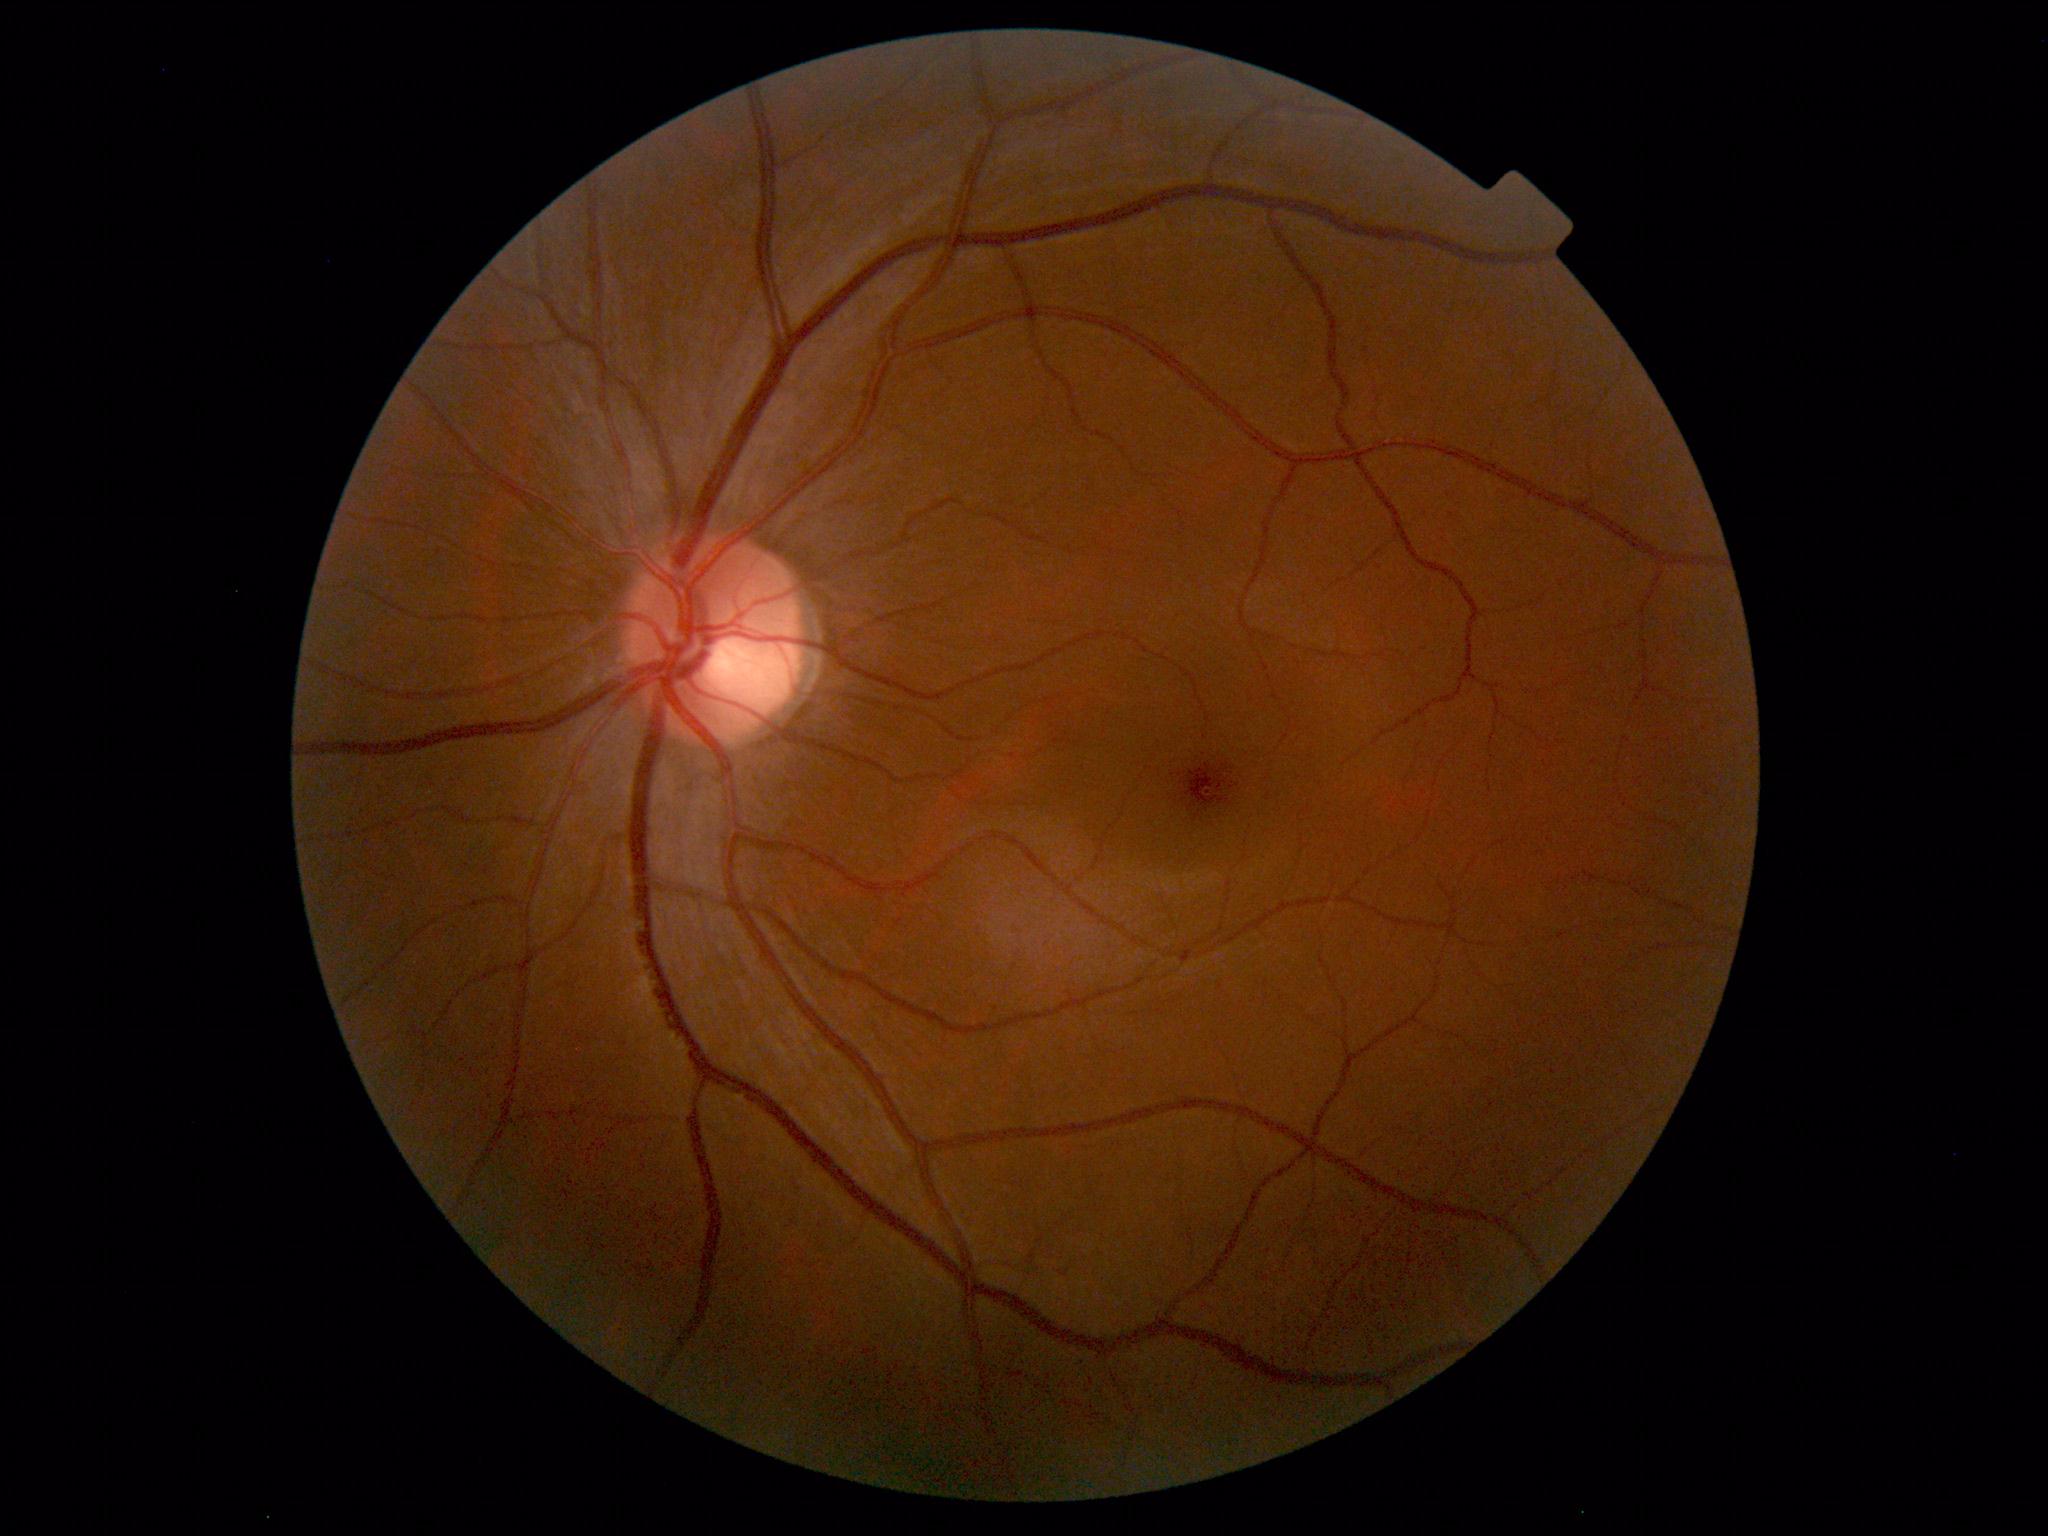

No retinal pathology identified.